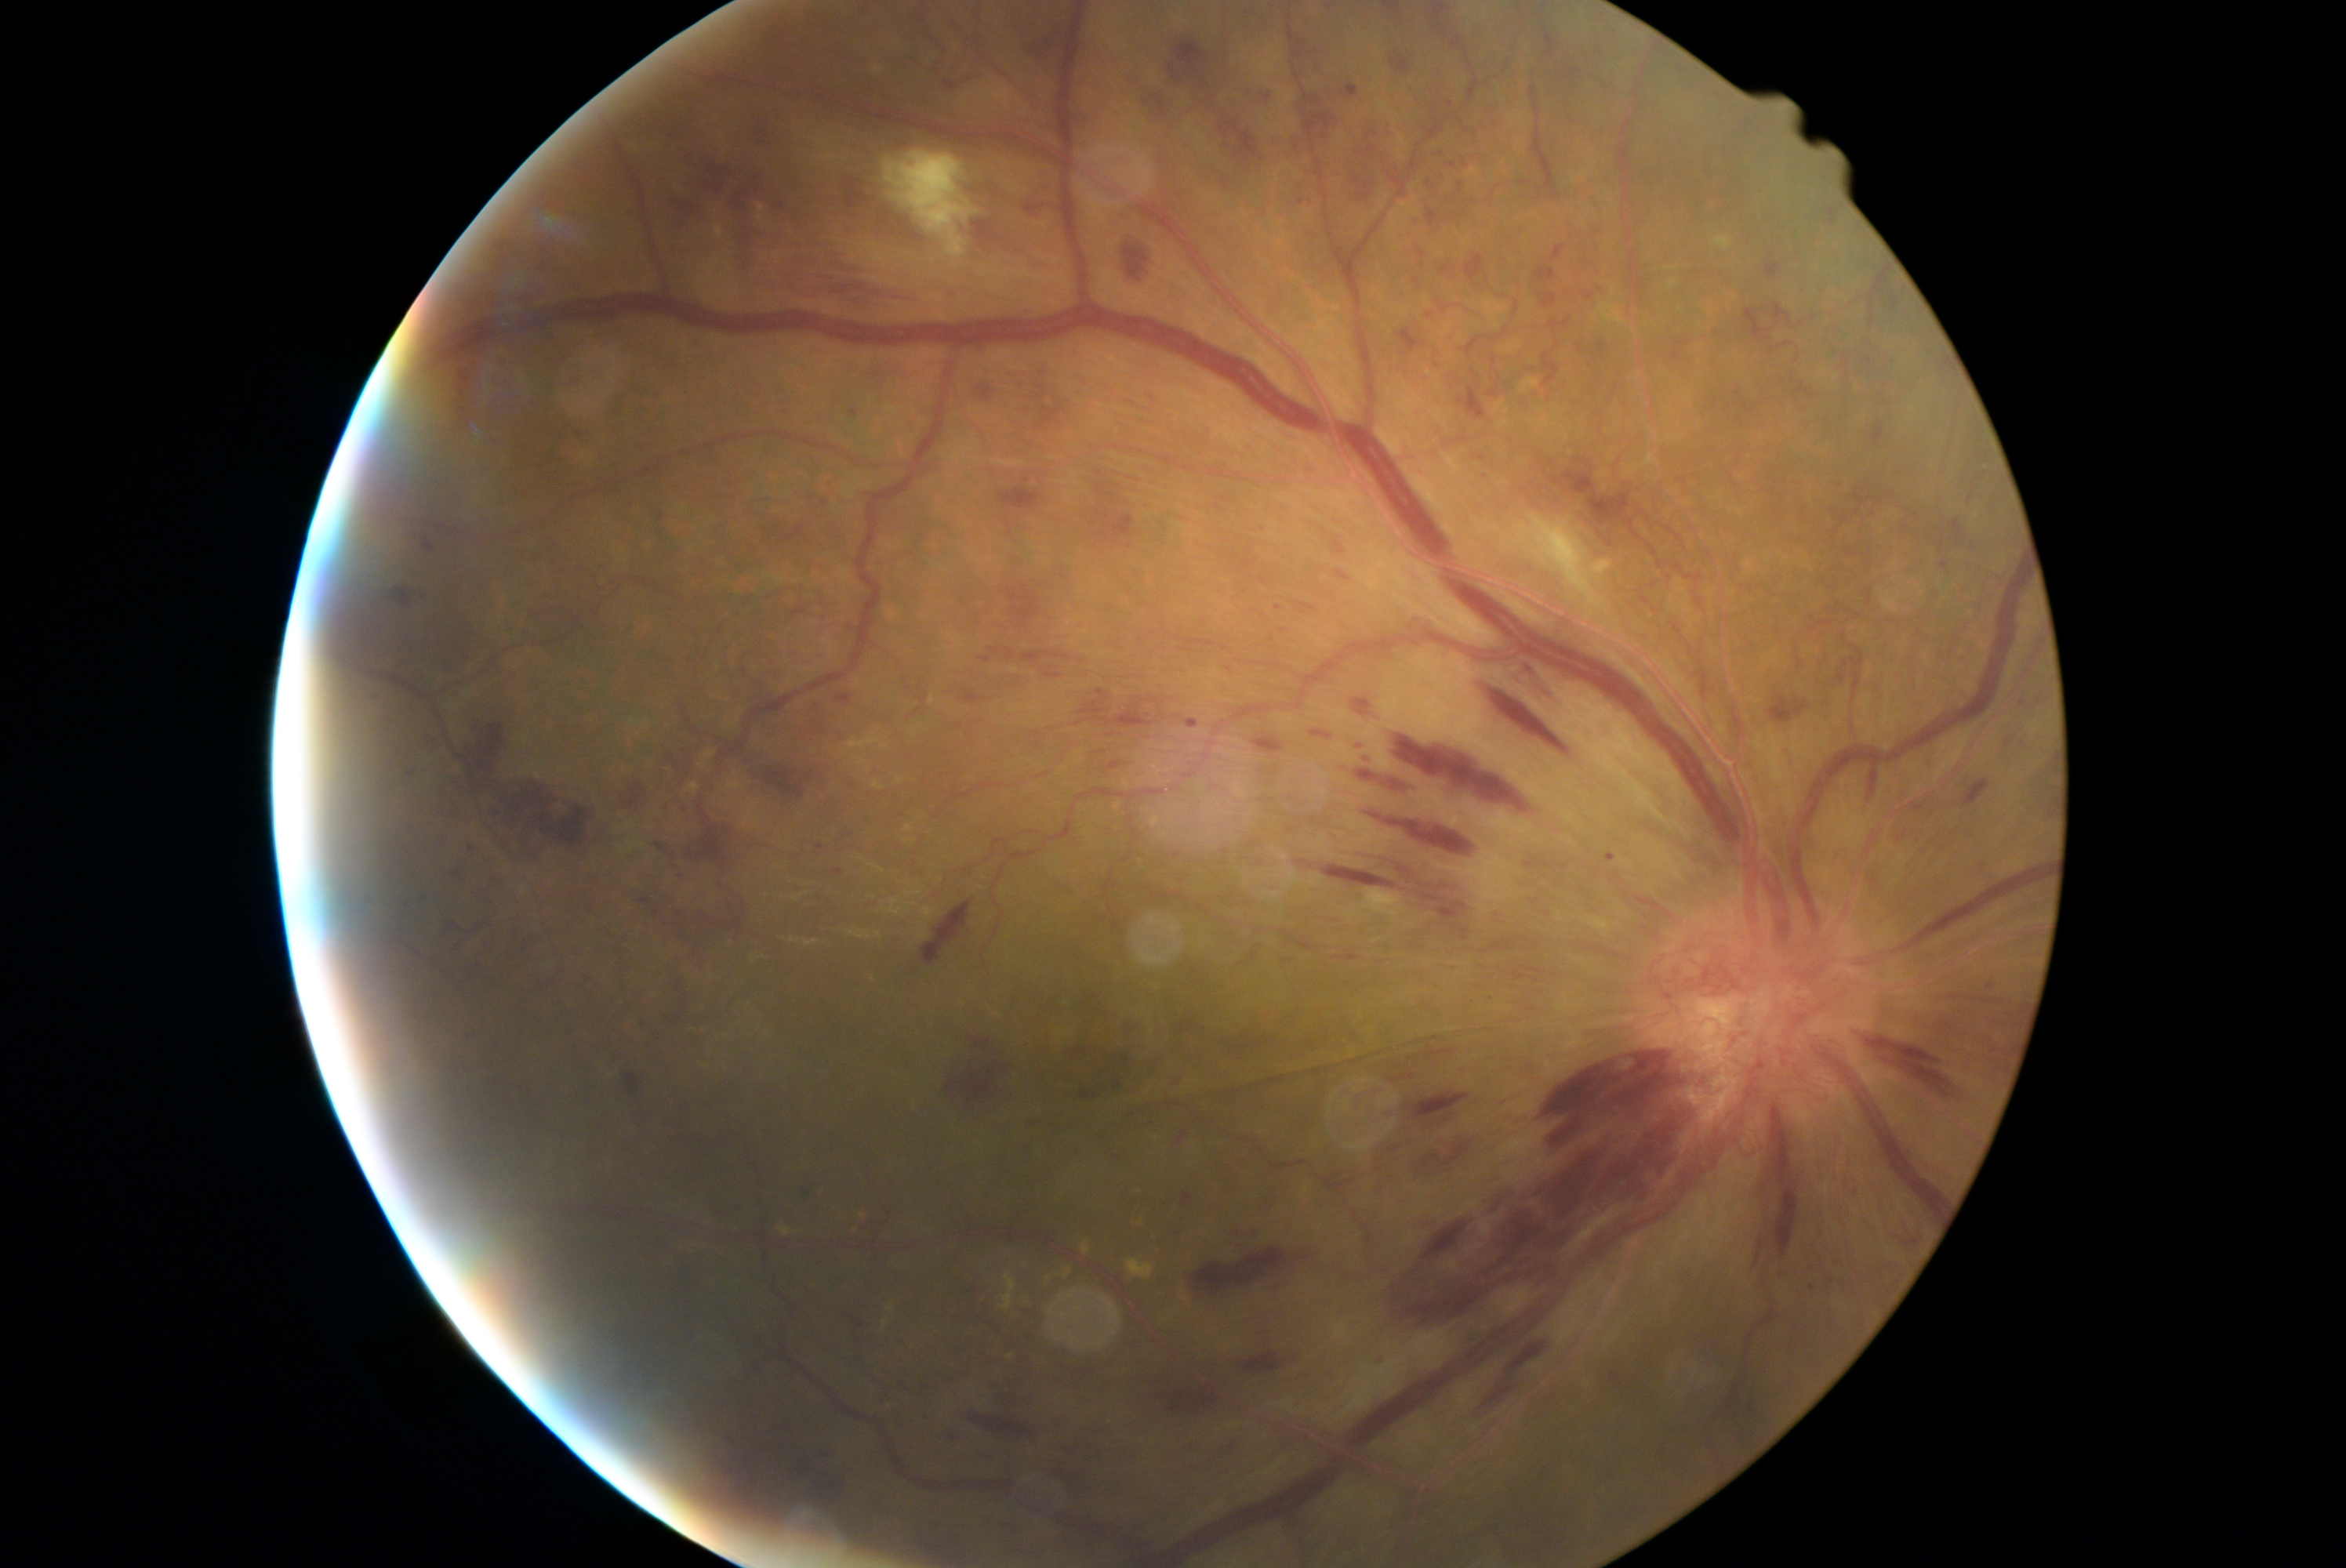

Diabetic retinopathy severity is 4/4 — neovascularization and/or vitreous/pre-retinal hemorrhage
Representative lesions:
- hemorrhages (partial): bbox(1006, 586, 1039, 630) | bbox(1291, 855, 1454, 912) | bbox(1404, 1094, 1470, 1127) | bbox(1948, 518, 1966, 545) | bbox(639, 899, 652, 904) | bbox(923, 901, 973, 965) | bbox(1428, 209, 1439, 227) | bbox(653, 504, 666, 528) | bbox(438, 833, 452, 844) | bbox(1635, 898, 1674, 918) | bbox(1665, 339, 1691, 365) | bbox(1298, 603, 1320, 614) | bbox(1368, 815, 1486, 862) | bbox(1903, 1240, 1919, 1246) | bbox(1000, 487, 1042, 512) | bbox(1177, 1017, 1196, 1036) | bbox(404, 766, 413, 779)
- Additional small hemorrhages near (1302; 203) | (1991; 986) | (692; 853)